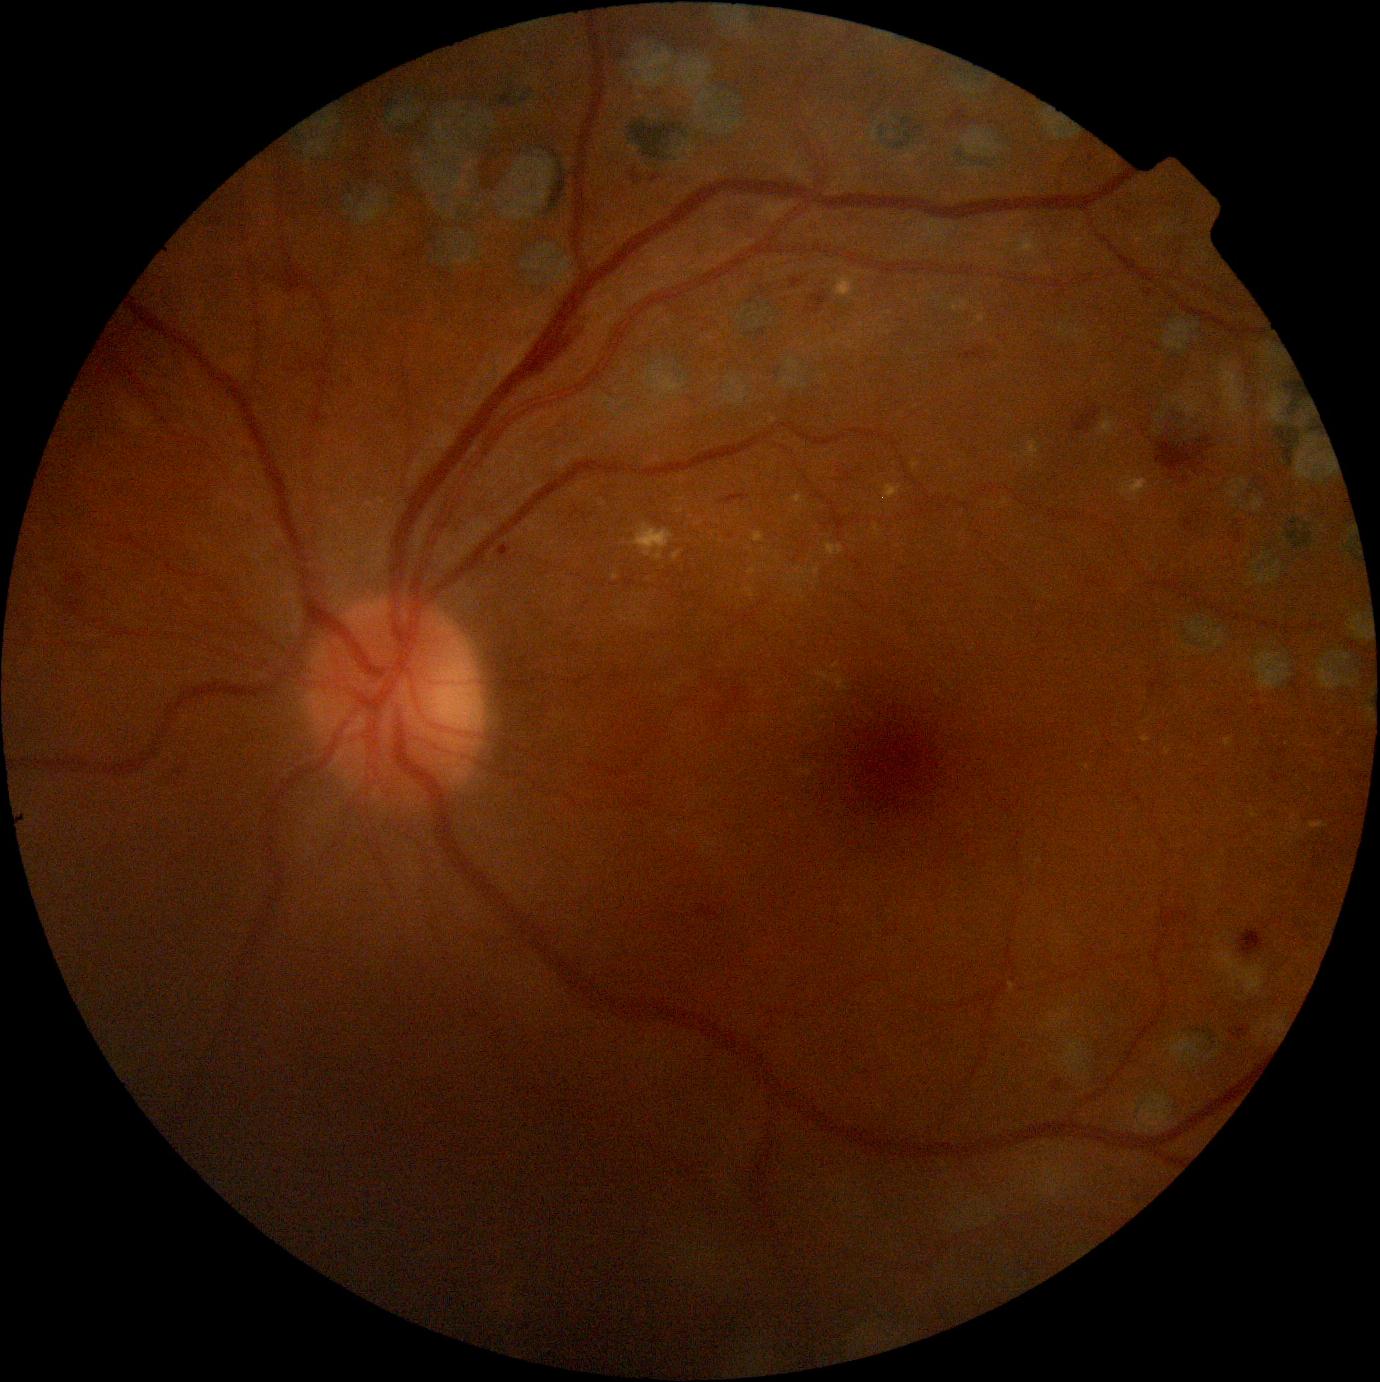 Diabetic retinopathy (DR) is moderate NPDR (grade 2)
Representative lesions:
* hard exudates (EXs) (more not shown): region(1310, 822, 1329, 830); region(742, 588, 755, 598); region(1010, 982, 1016, 994); region(874, 524, 882, 539); region(883, 485, 902, 501); region(1003, 234, 1041, 258); region(798, 589, 806, 601); region(1099, 415, 1119, 438); region(835, 277, 855, 298)
* Additional small EXs near 615, 577